2352x1568px · color fundus photograph · 45° FOV: 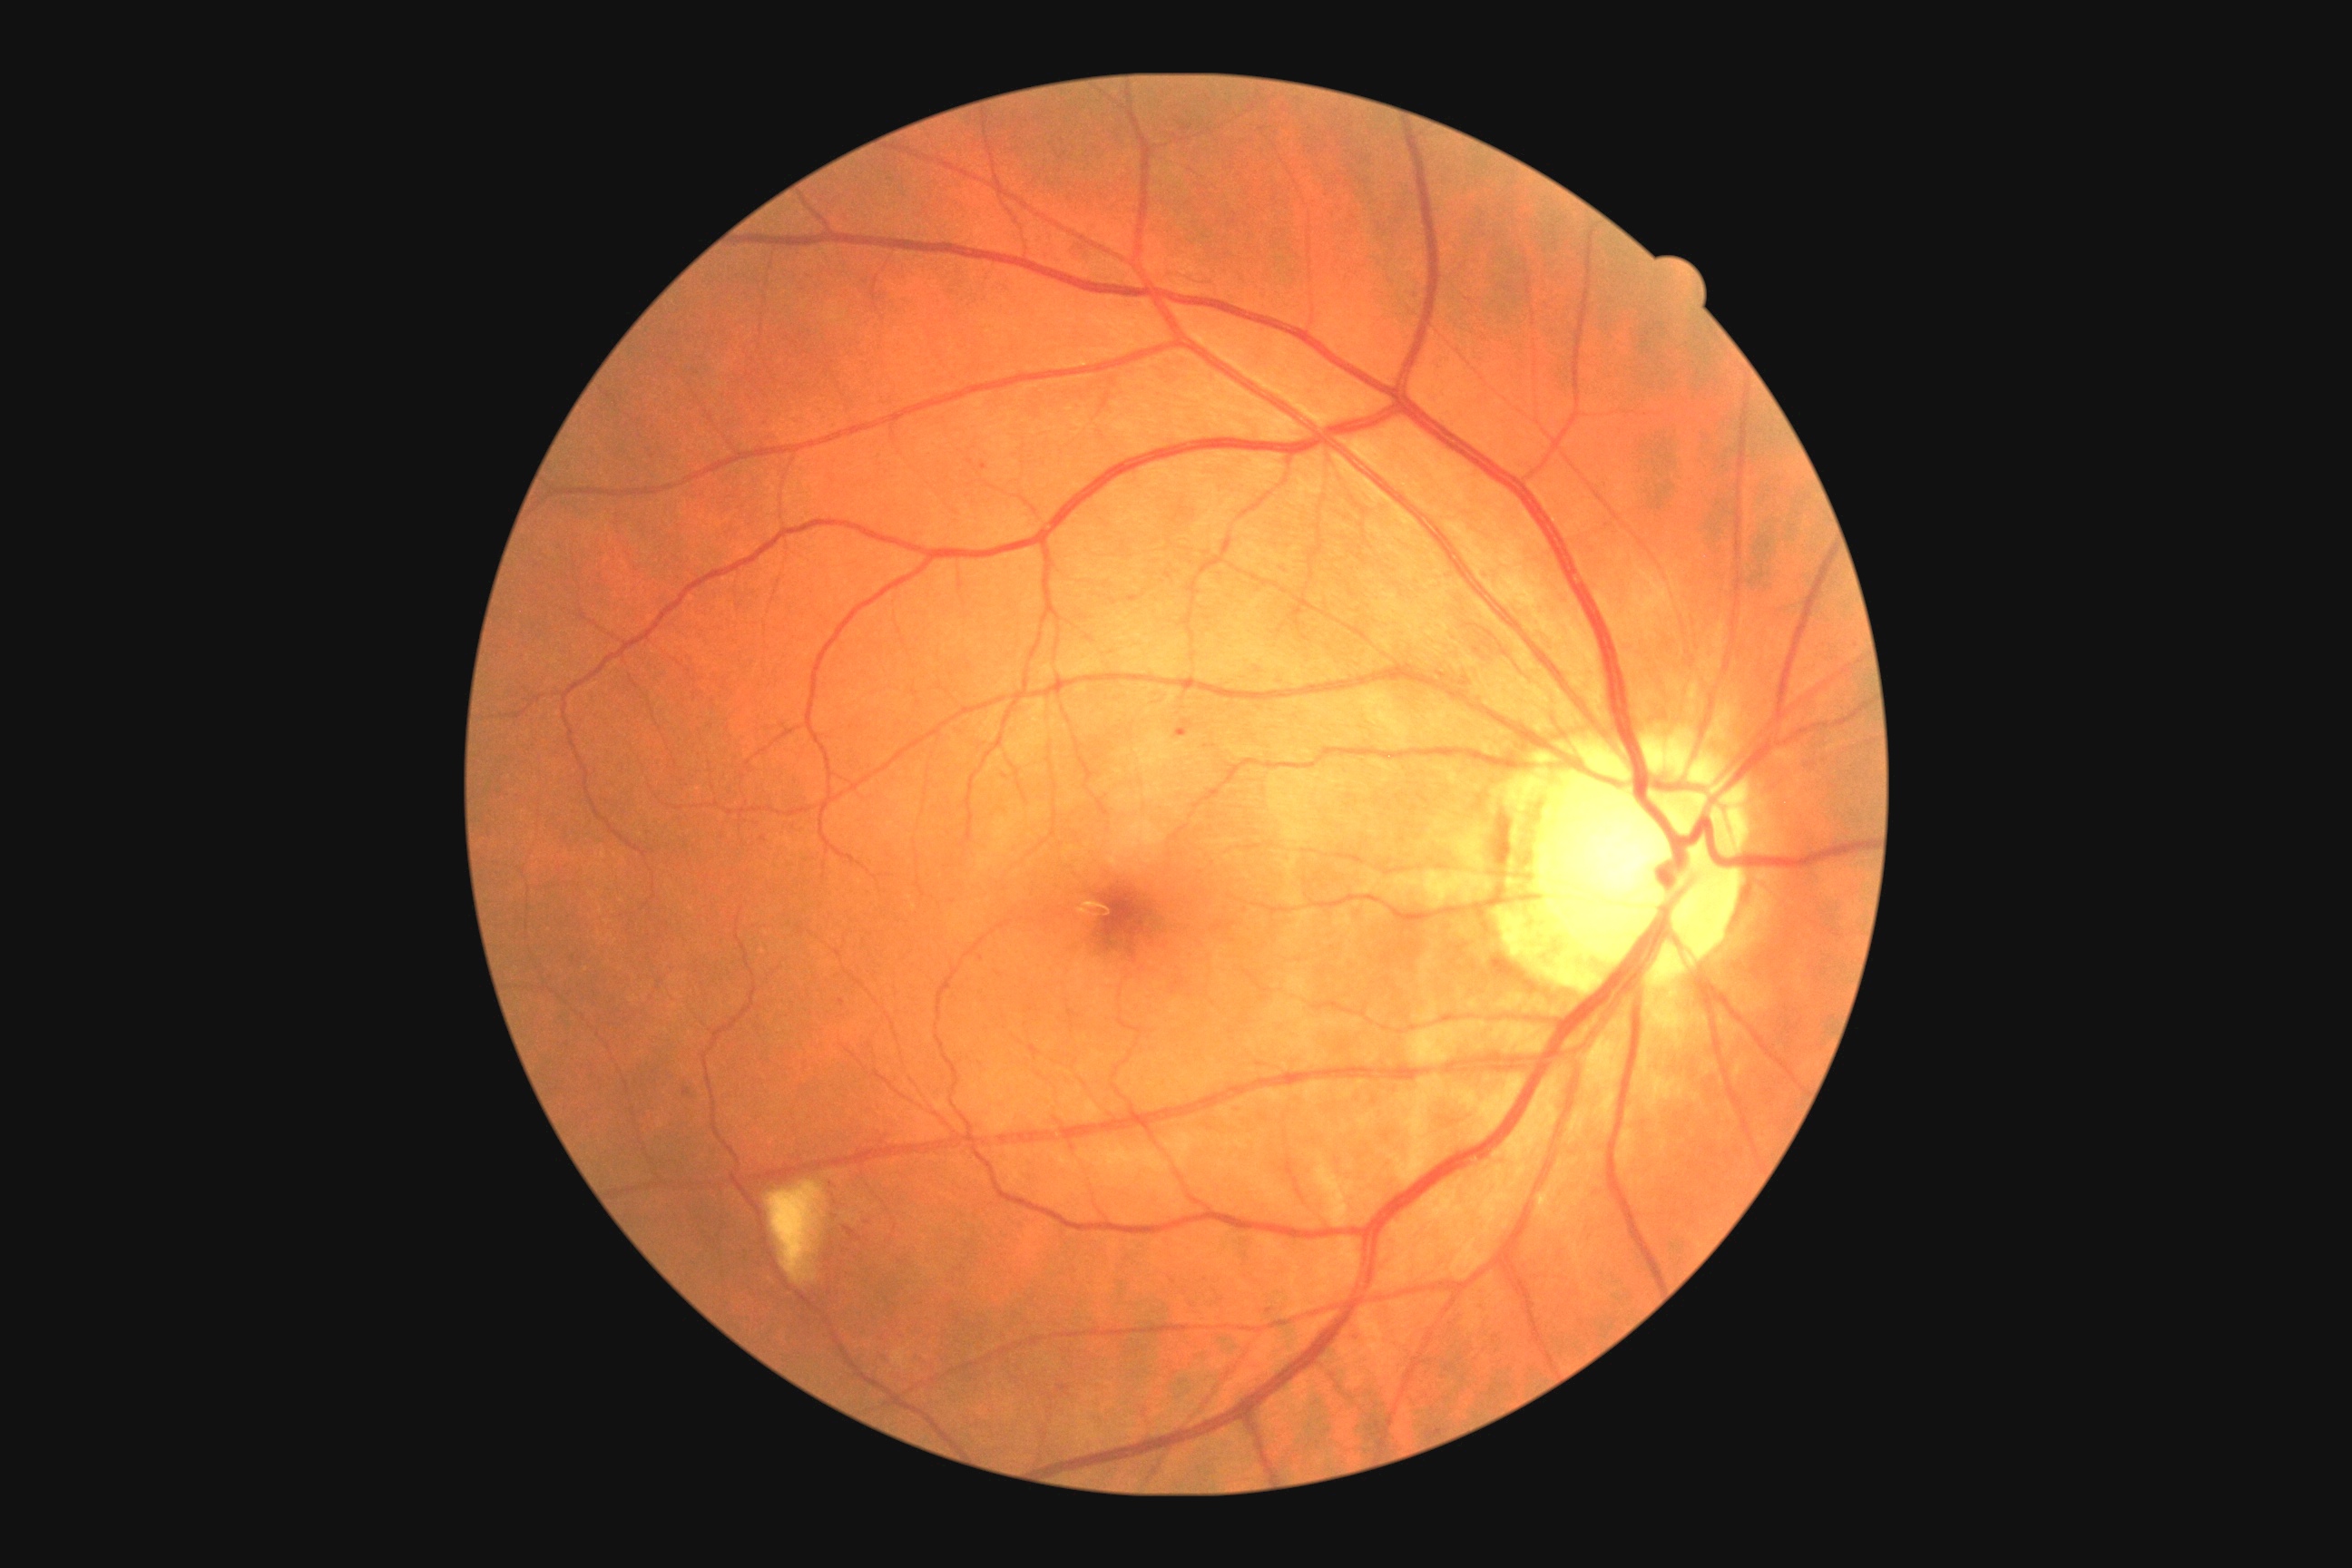

Diabetic retinopathy (DR): grade 2 (moderate NPDR)
Representative lesions:
* microaneurysms (MAs) (partial): region(683, 1088, 691, 1095); region(1175, 720, 1193, 738); region(839, 999, 847, 1006)
* Small MAs approximately at 984/467; 835/1217; 764/839; 867/1223
* hemorrhages (HEs): region(843, 1226, 863, 1242)
* hard exudates (EXs): none detected
* soft exudates (SEs): region(767, 1182, 827, 1286)